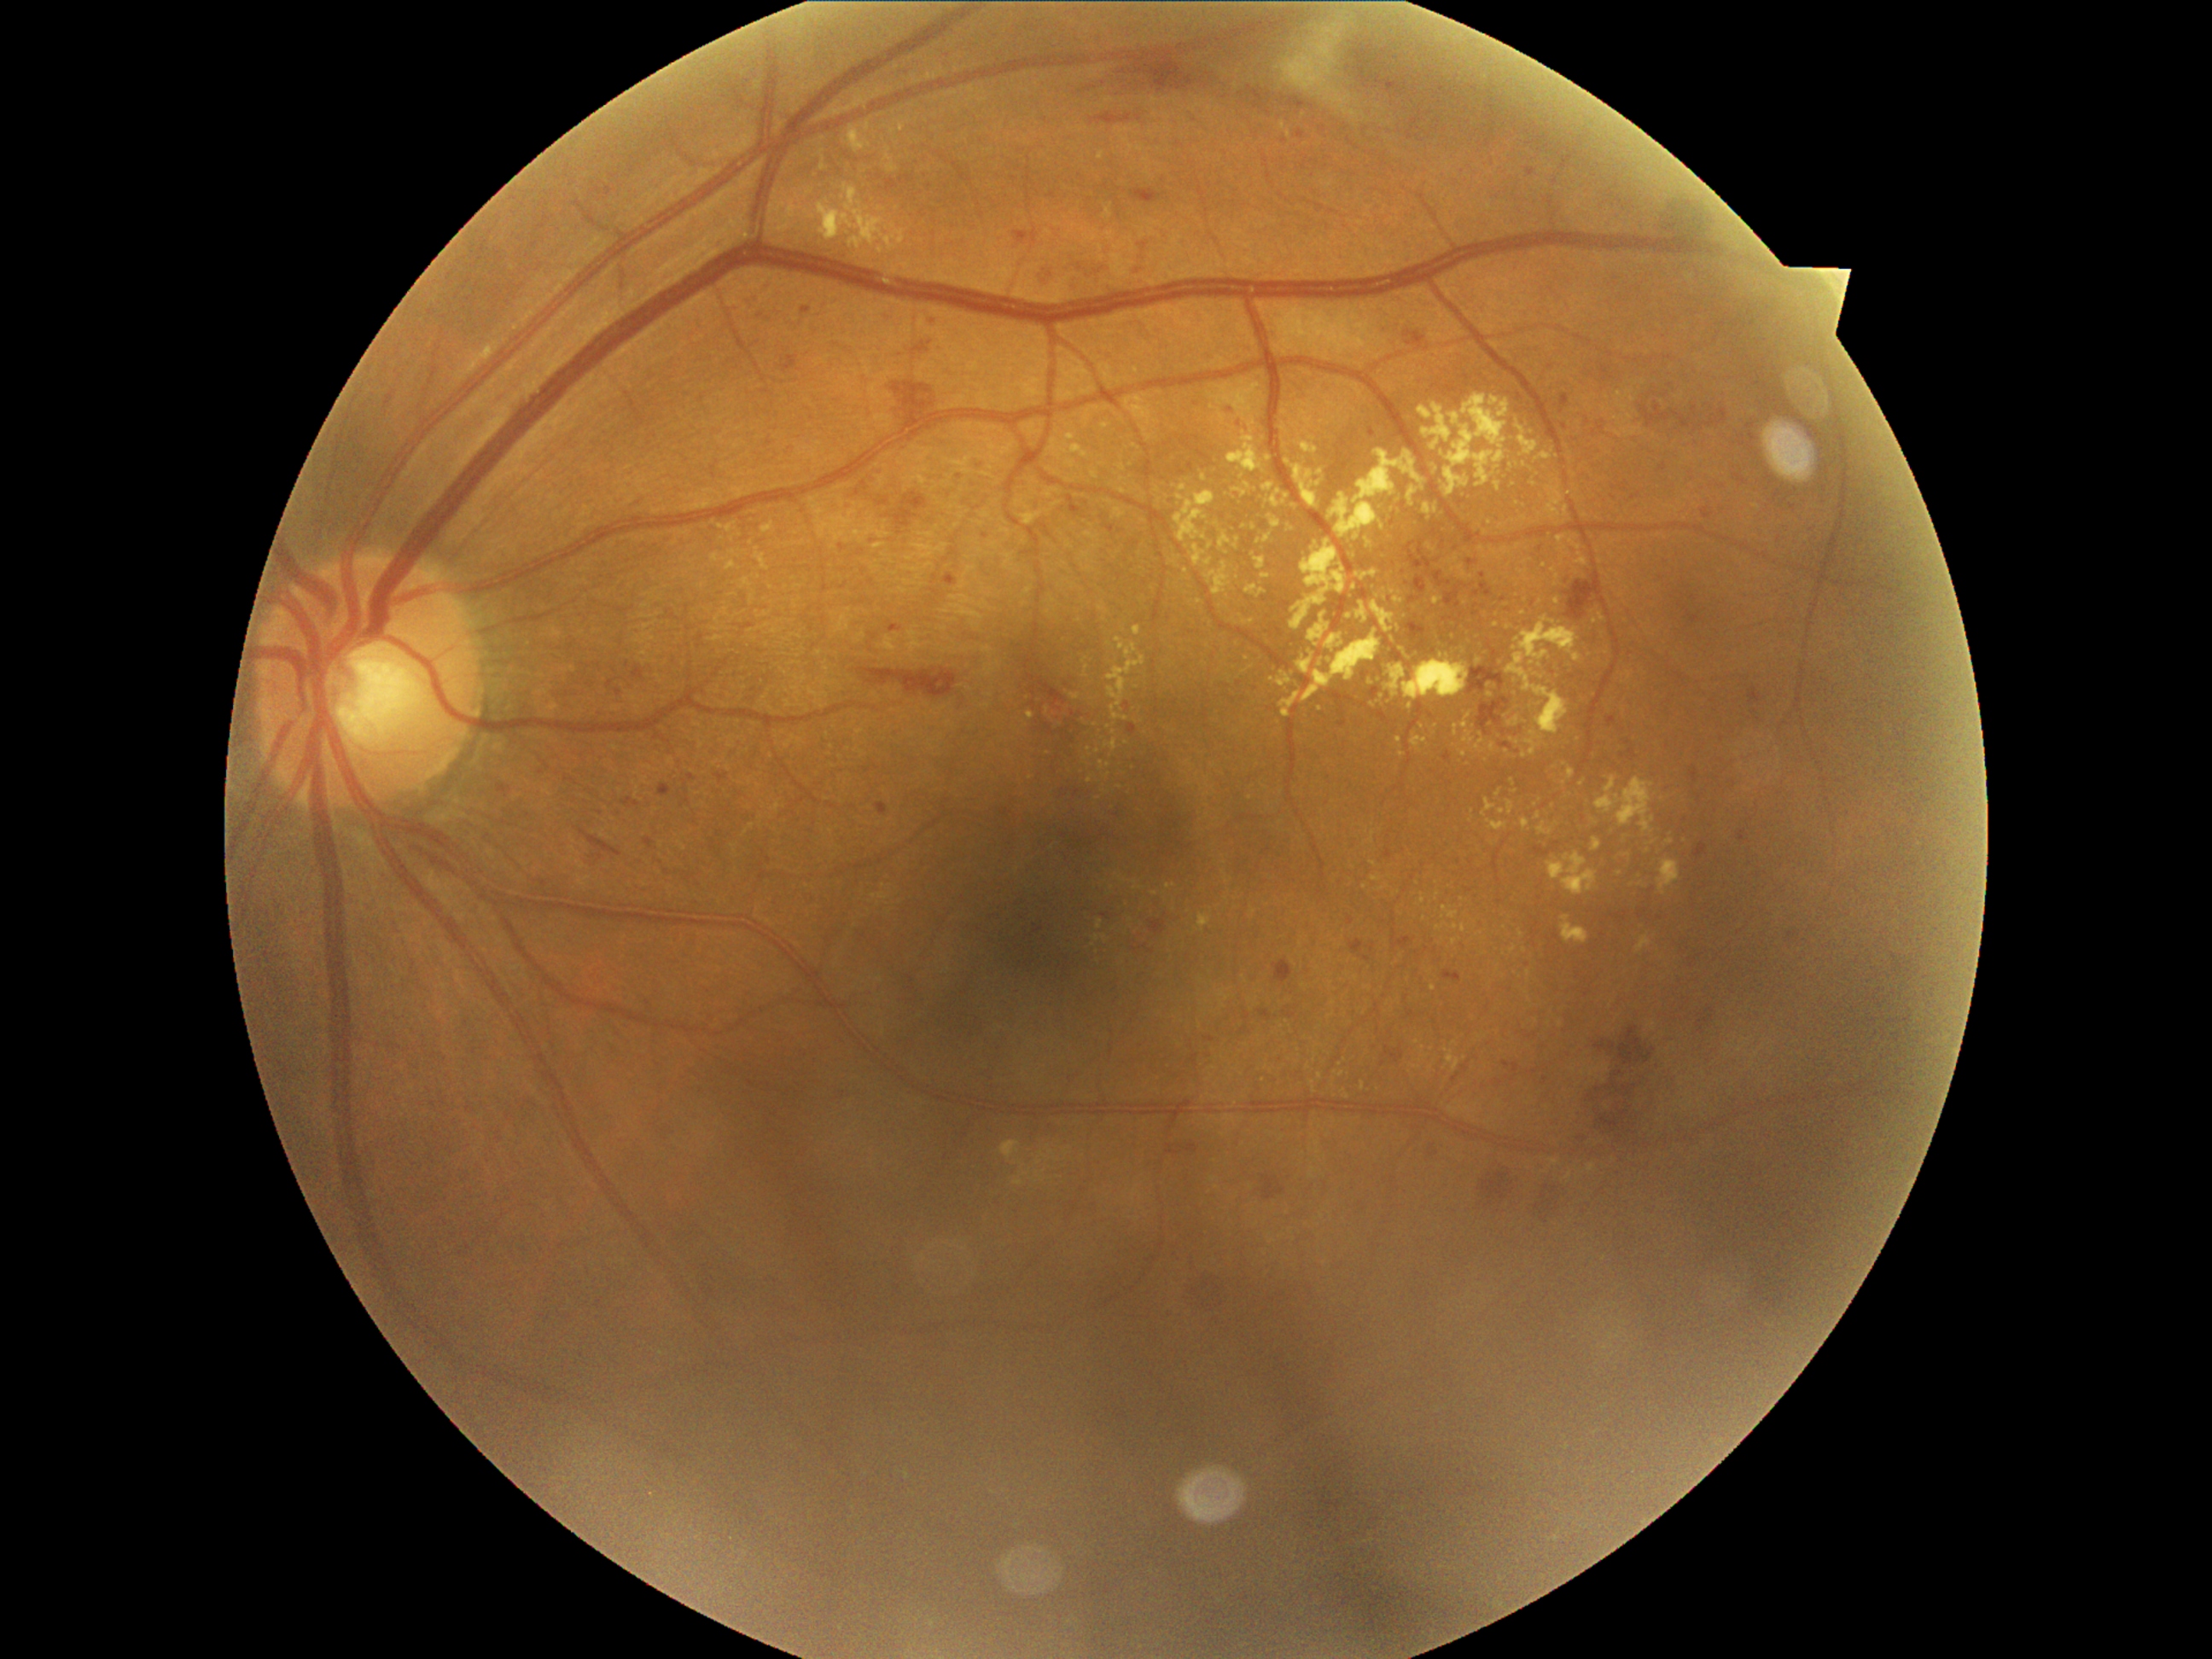
Diabetic retinopathy (DR): 2/4
Selected lesions:
hard exudates (EXs) (partial): (x1=895, y1=119, x2=912, y2=132); (x1=1271, y1=672, x2=1293, y2=687); (x1=1303, y1=631, x2=1382, y2=702); (x1=1179, y1=484, x2=1187, y2=492); (x1=1508, y1=801, x2=1515, y2=817); (x1=1563, y1=916, x2=1588, y2=945); (x1=1269, y1=515, x2=1283, y2=528); (x1=1167, y1=883, x2=1175, y2=890); (x1=1349, y1=550, x2=1358, y2=561)
EXs (small, approximate centers) near <point>1105, 938</point>; <point>1400, 593</point>; <point>1535, 805</point>; <point>1529, 975</point>; <point>1204, 478</point>; <point>1759, 783</point>; <point>1244, 527</point>; <point>1254, 528</point>; <point>1483, 549</point>; <point>1381, 889</point>